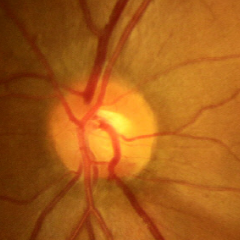

Optic disc photograph demonstrating early-stage glaucoma.